2048 x 1536 pixels: 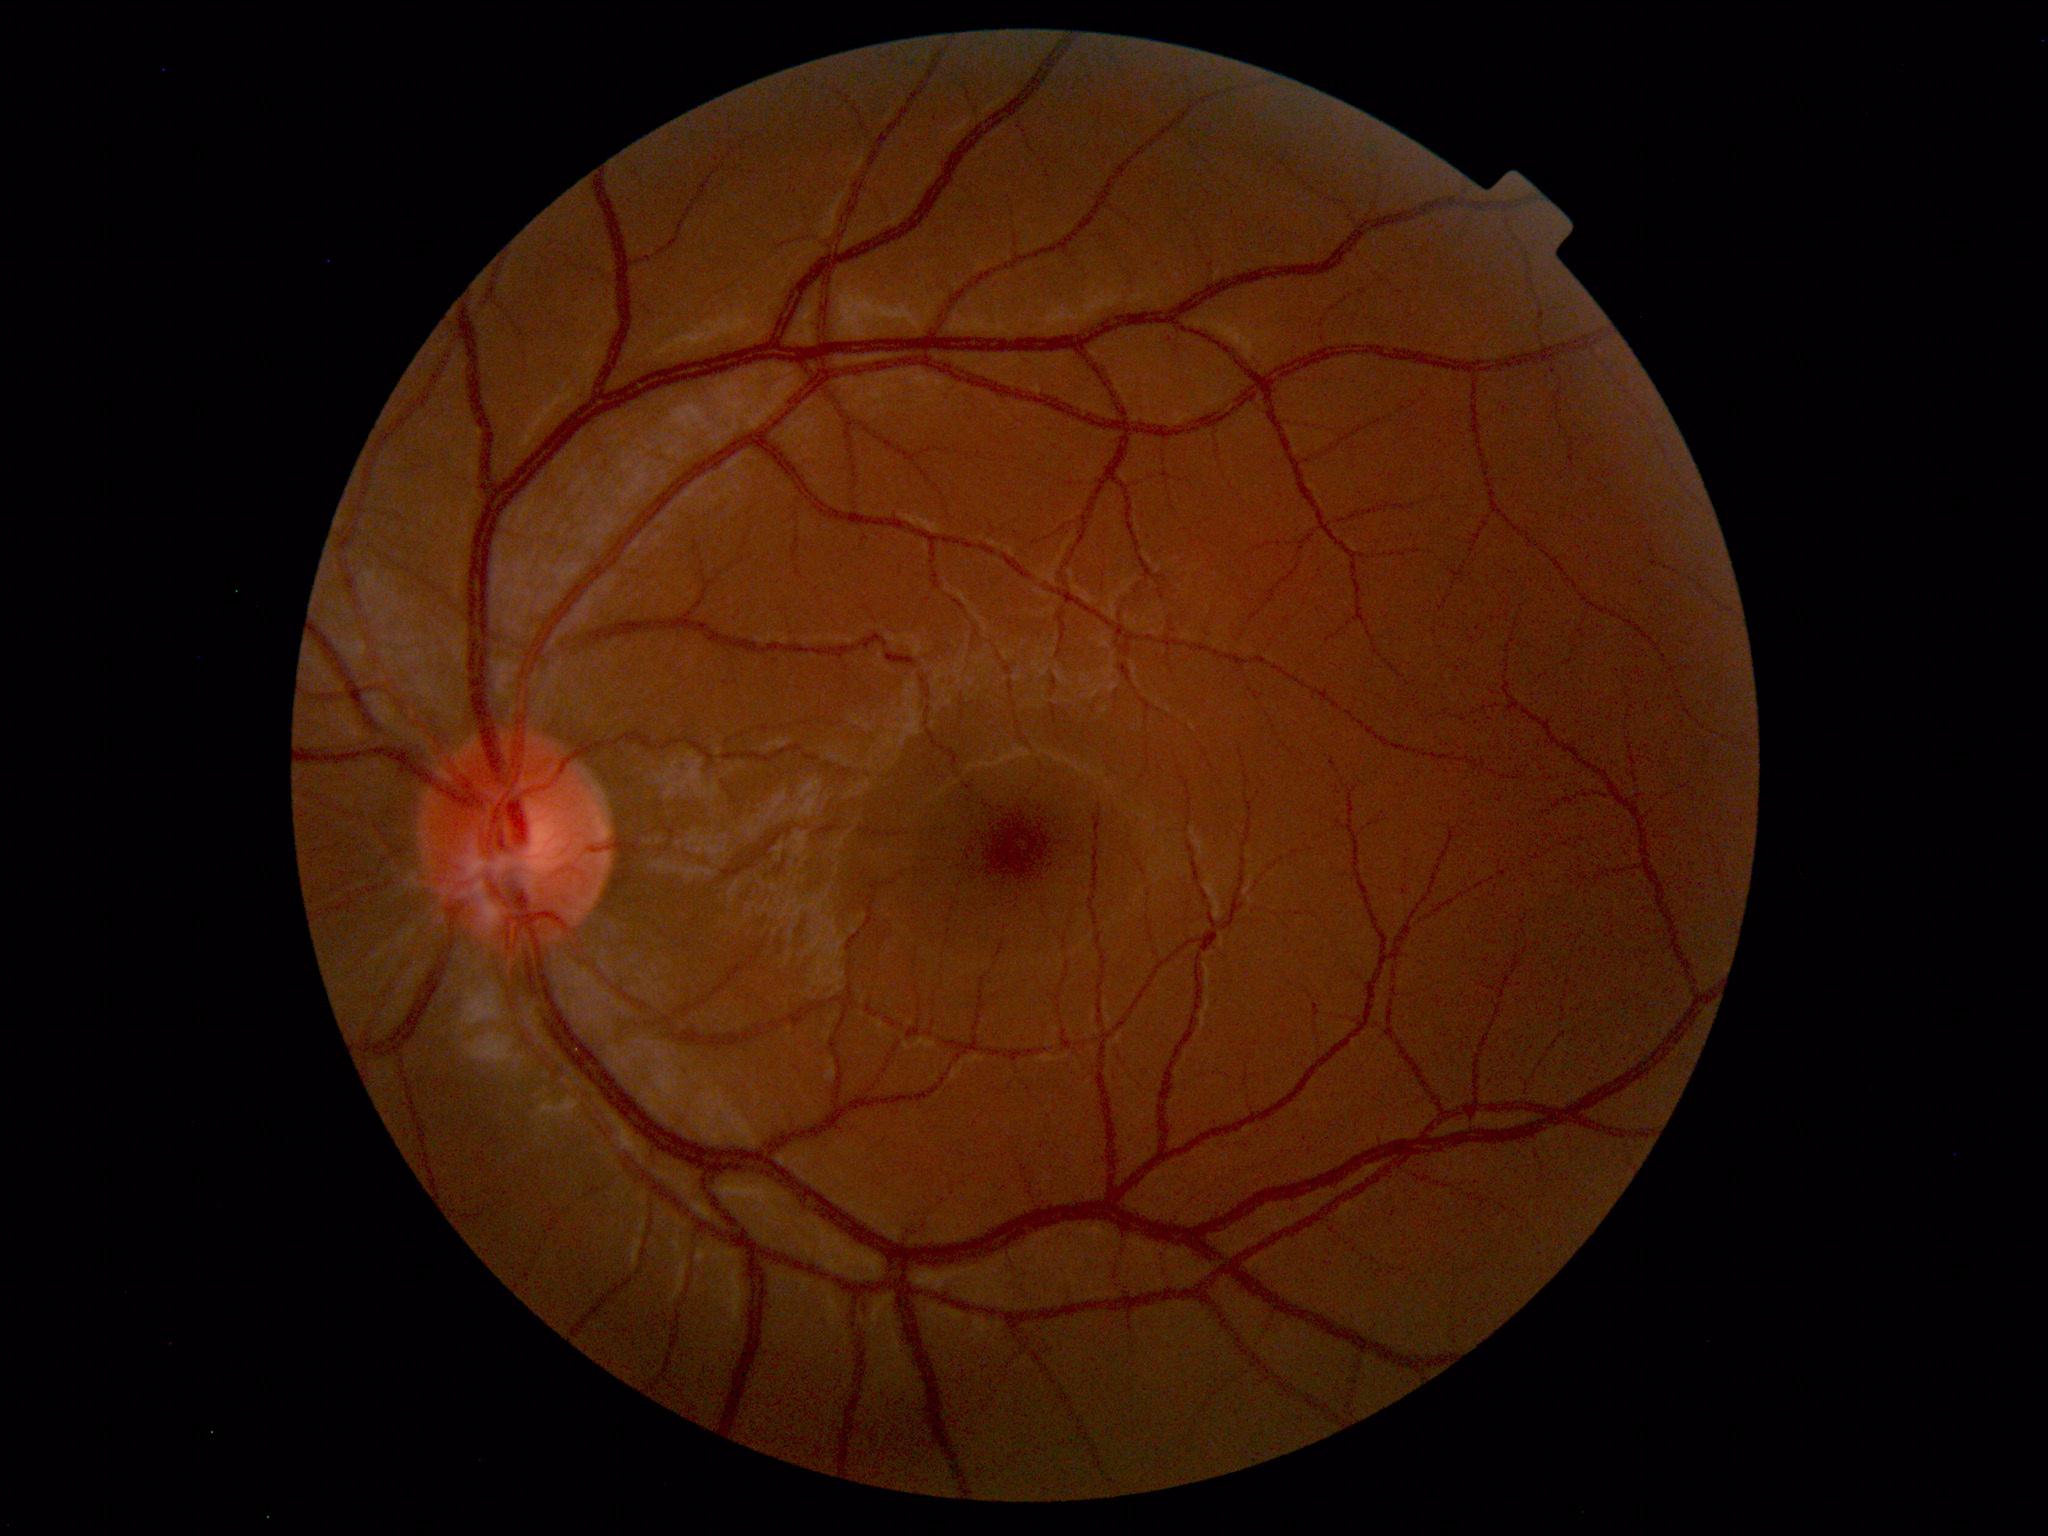
Diagnosis: normal.